Fundus photo: 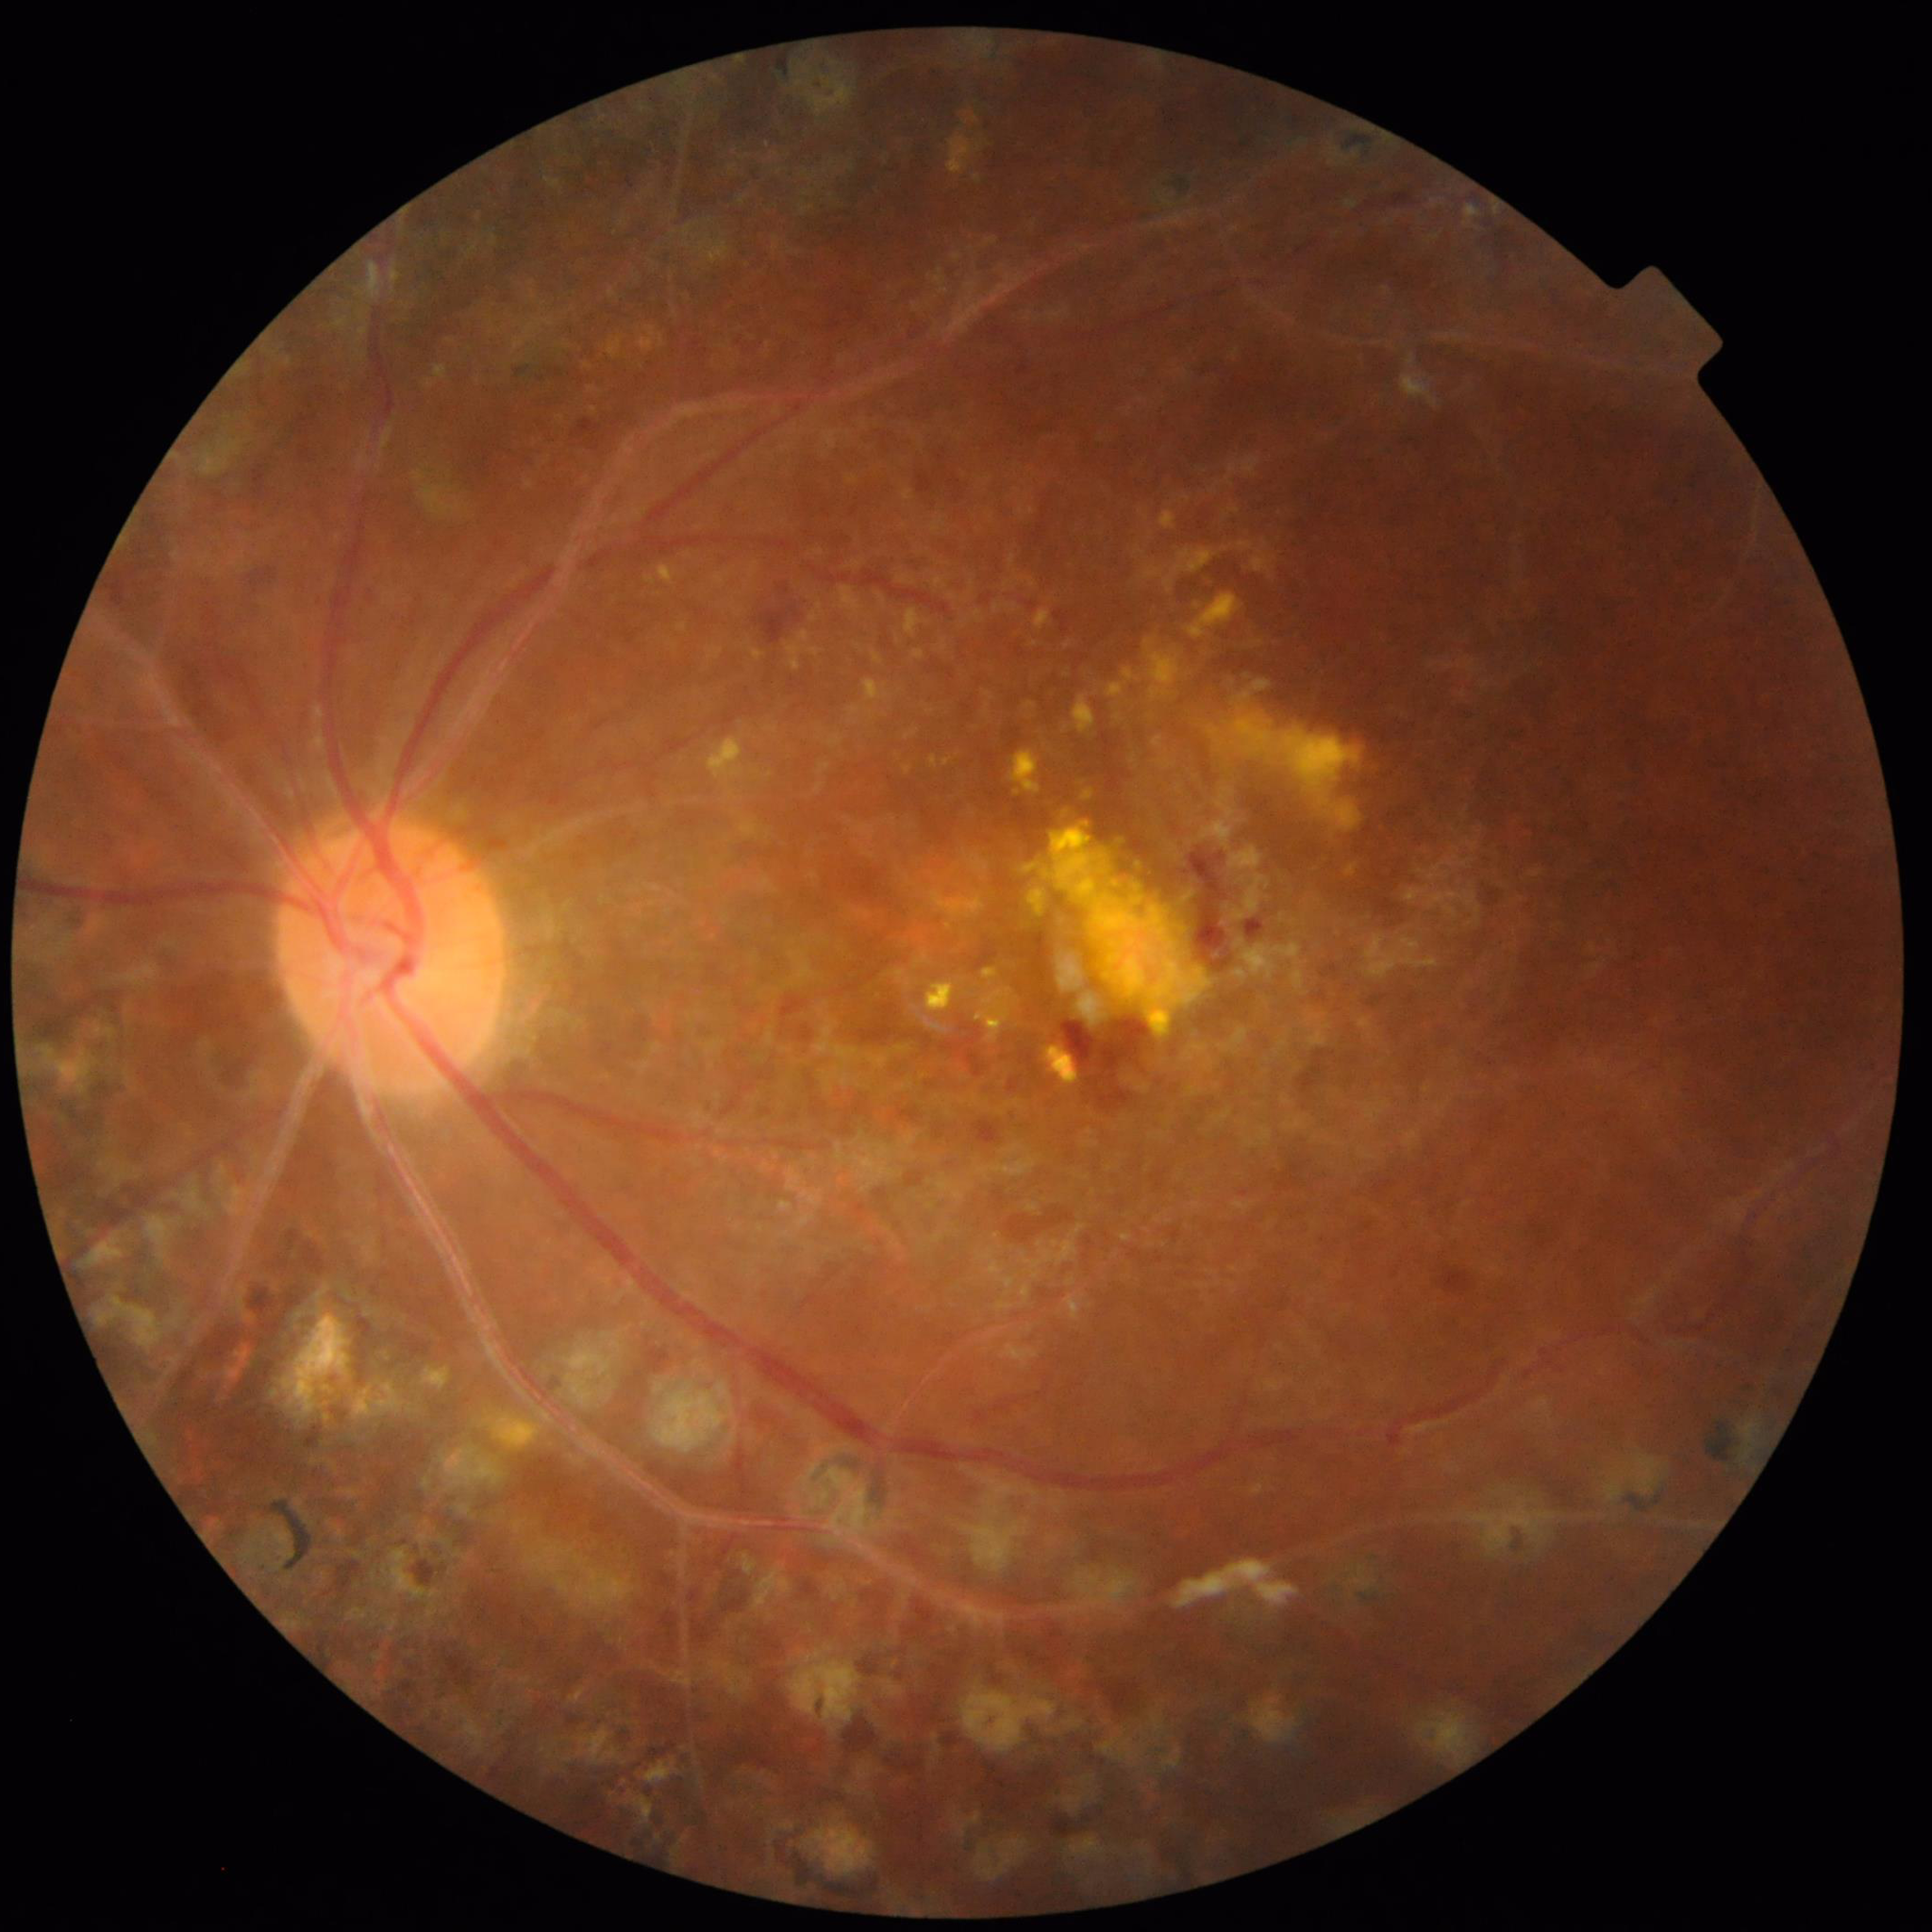

Image quality: reduced — blur. From a patient with diabetic retinopathy (DR).